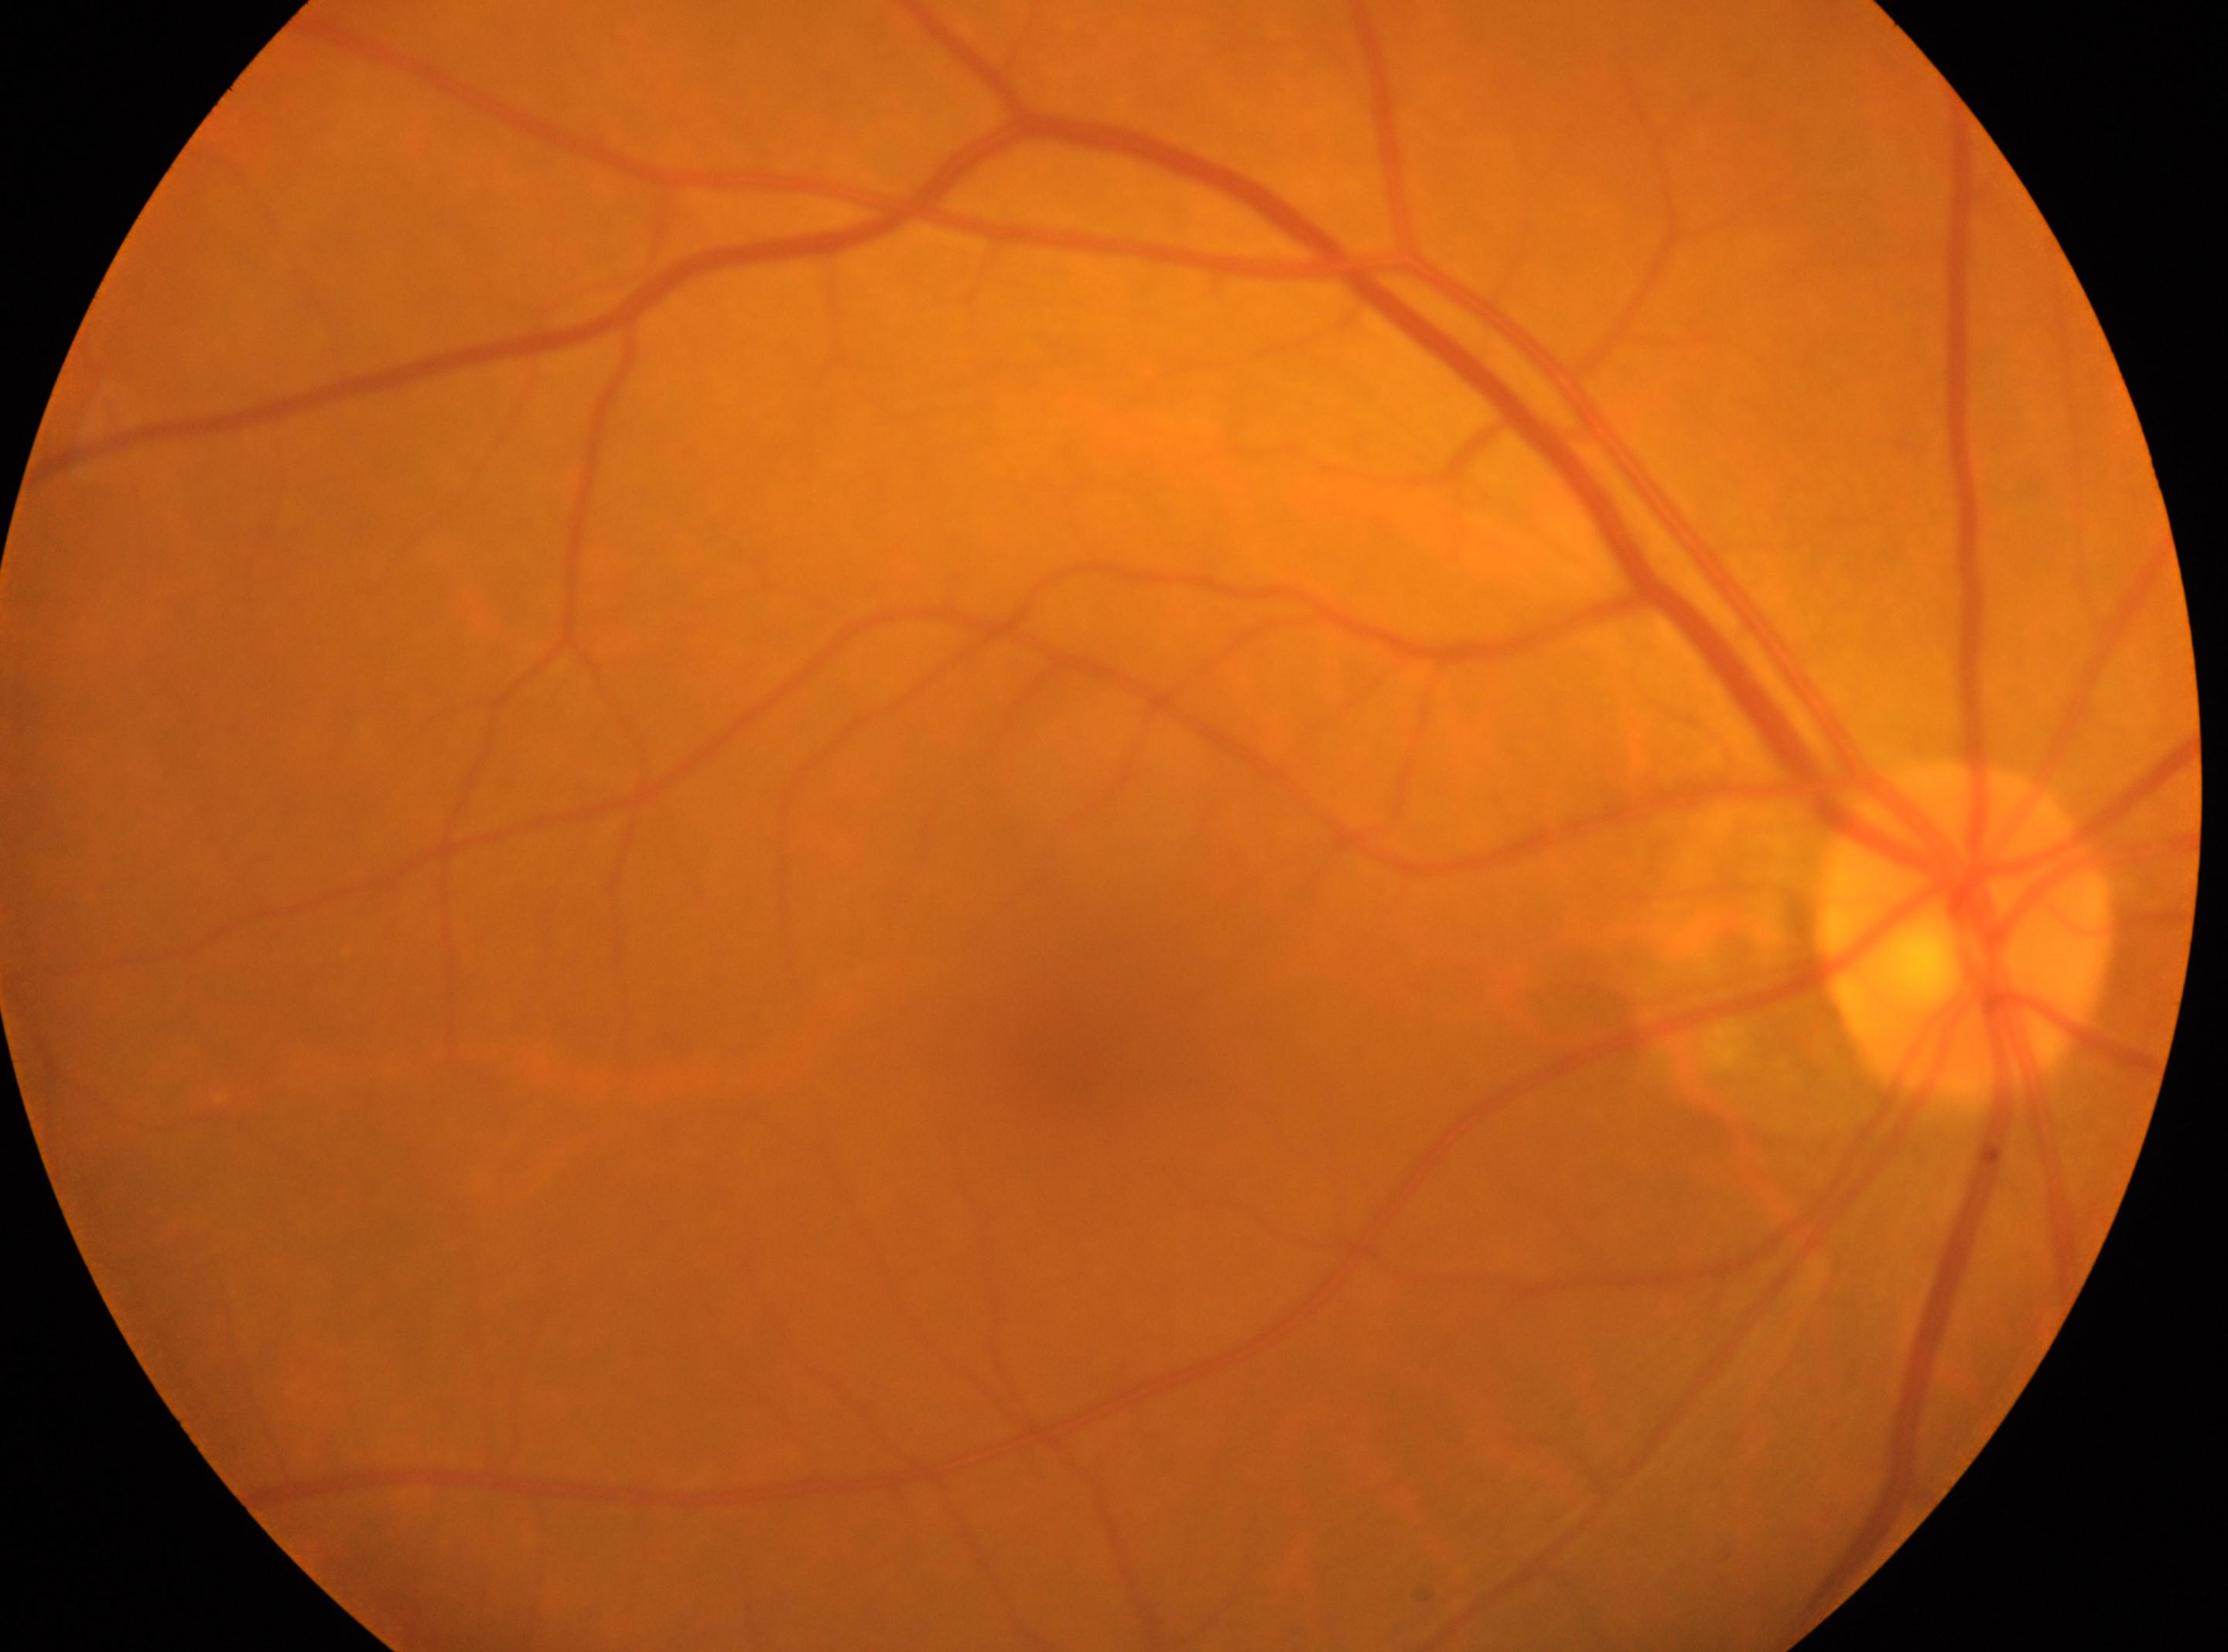
Q: Locate the fovea.
A: (x: 1055, y: 1043)
Q: What is the DR grade?
A: grade 0 (no apparent retinopathy)
Q: Optic disc center?
A: (x: 1965, y: 930)
Q: DR impression?
A: No apparent diabetic retinopathy
Q: What is the laterality?
A: the right eye